Tabletop color fundus camera image, 50° FOV — 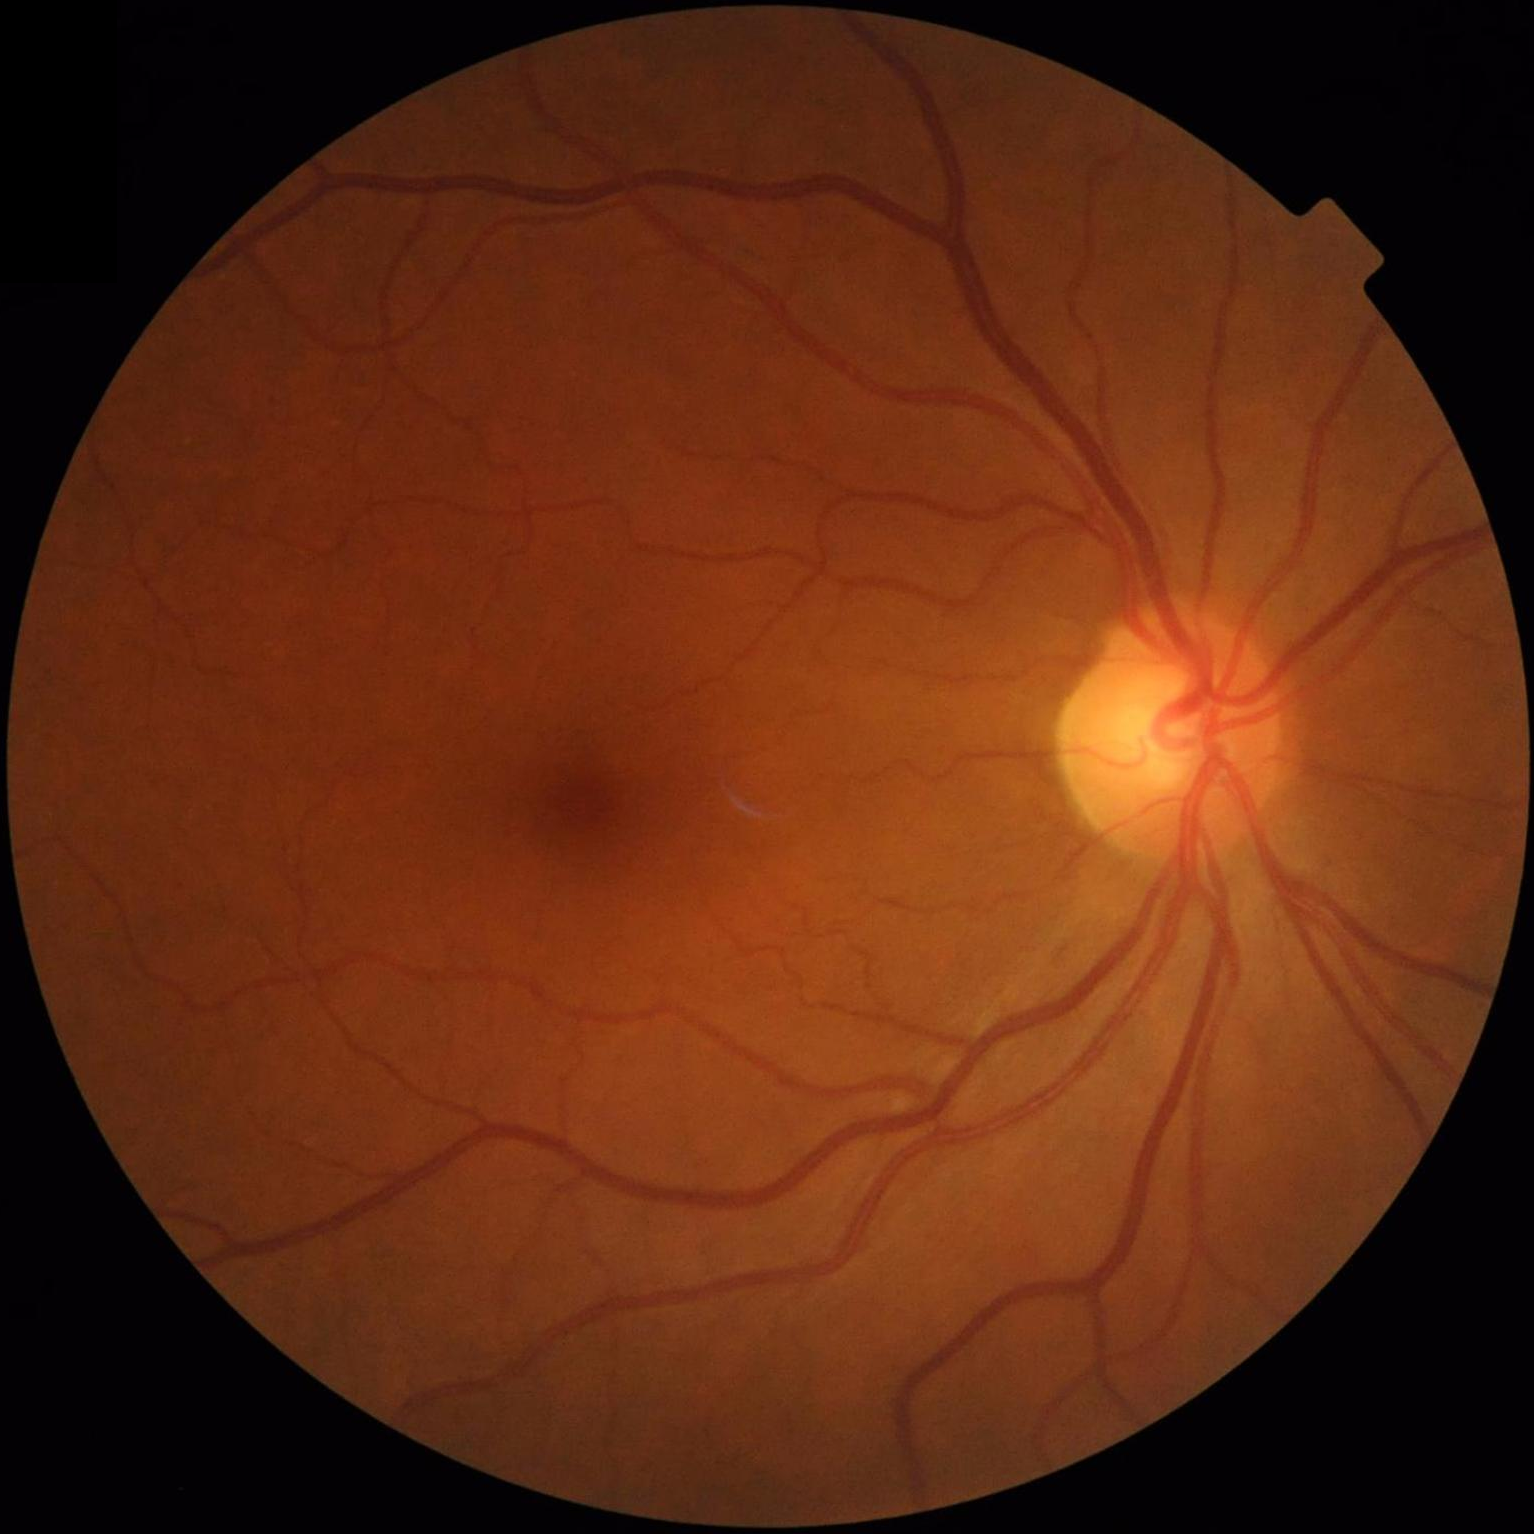

Good dynamic range.
Image is sharp throughout the field.
Overall quality is good and the image is gradable.
Illumination and color balance are good.